Image size 1924x1556, UWF retinal mosaic.
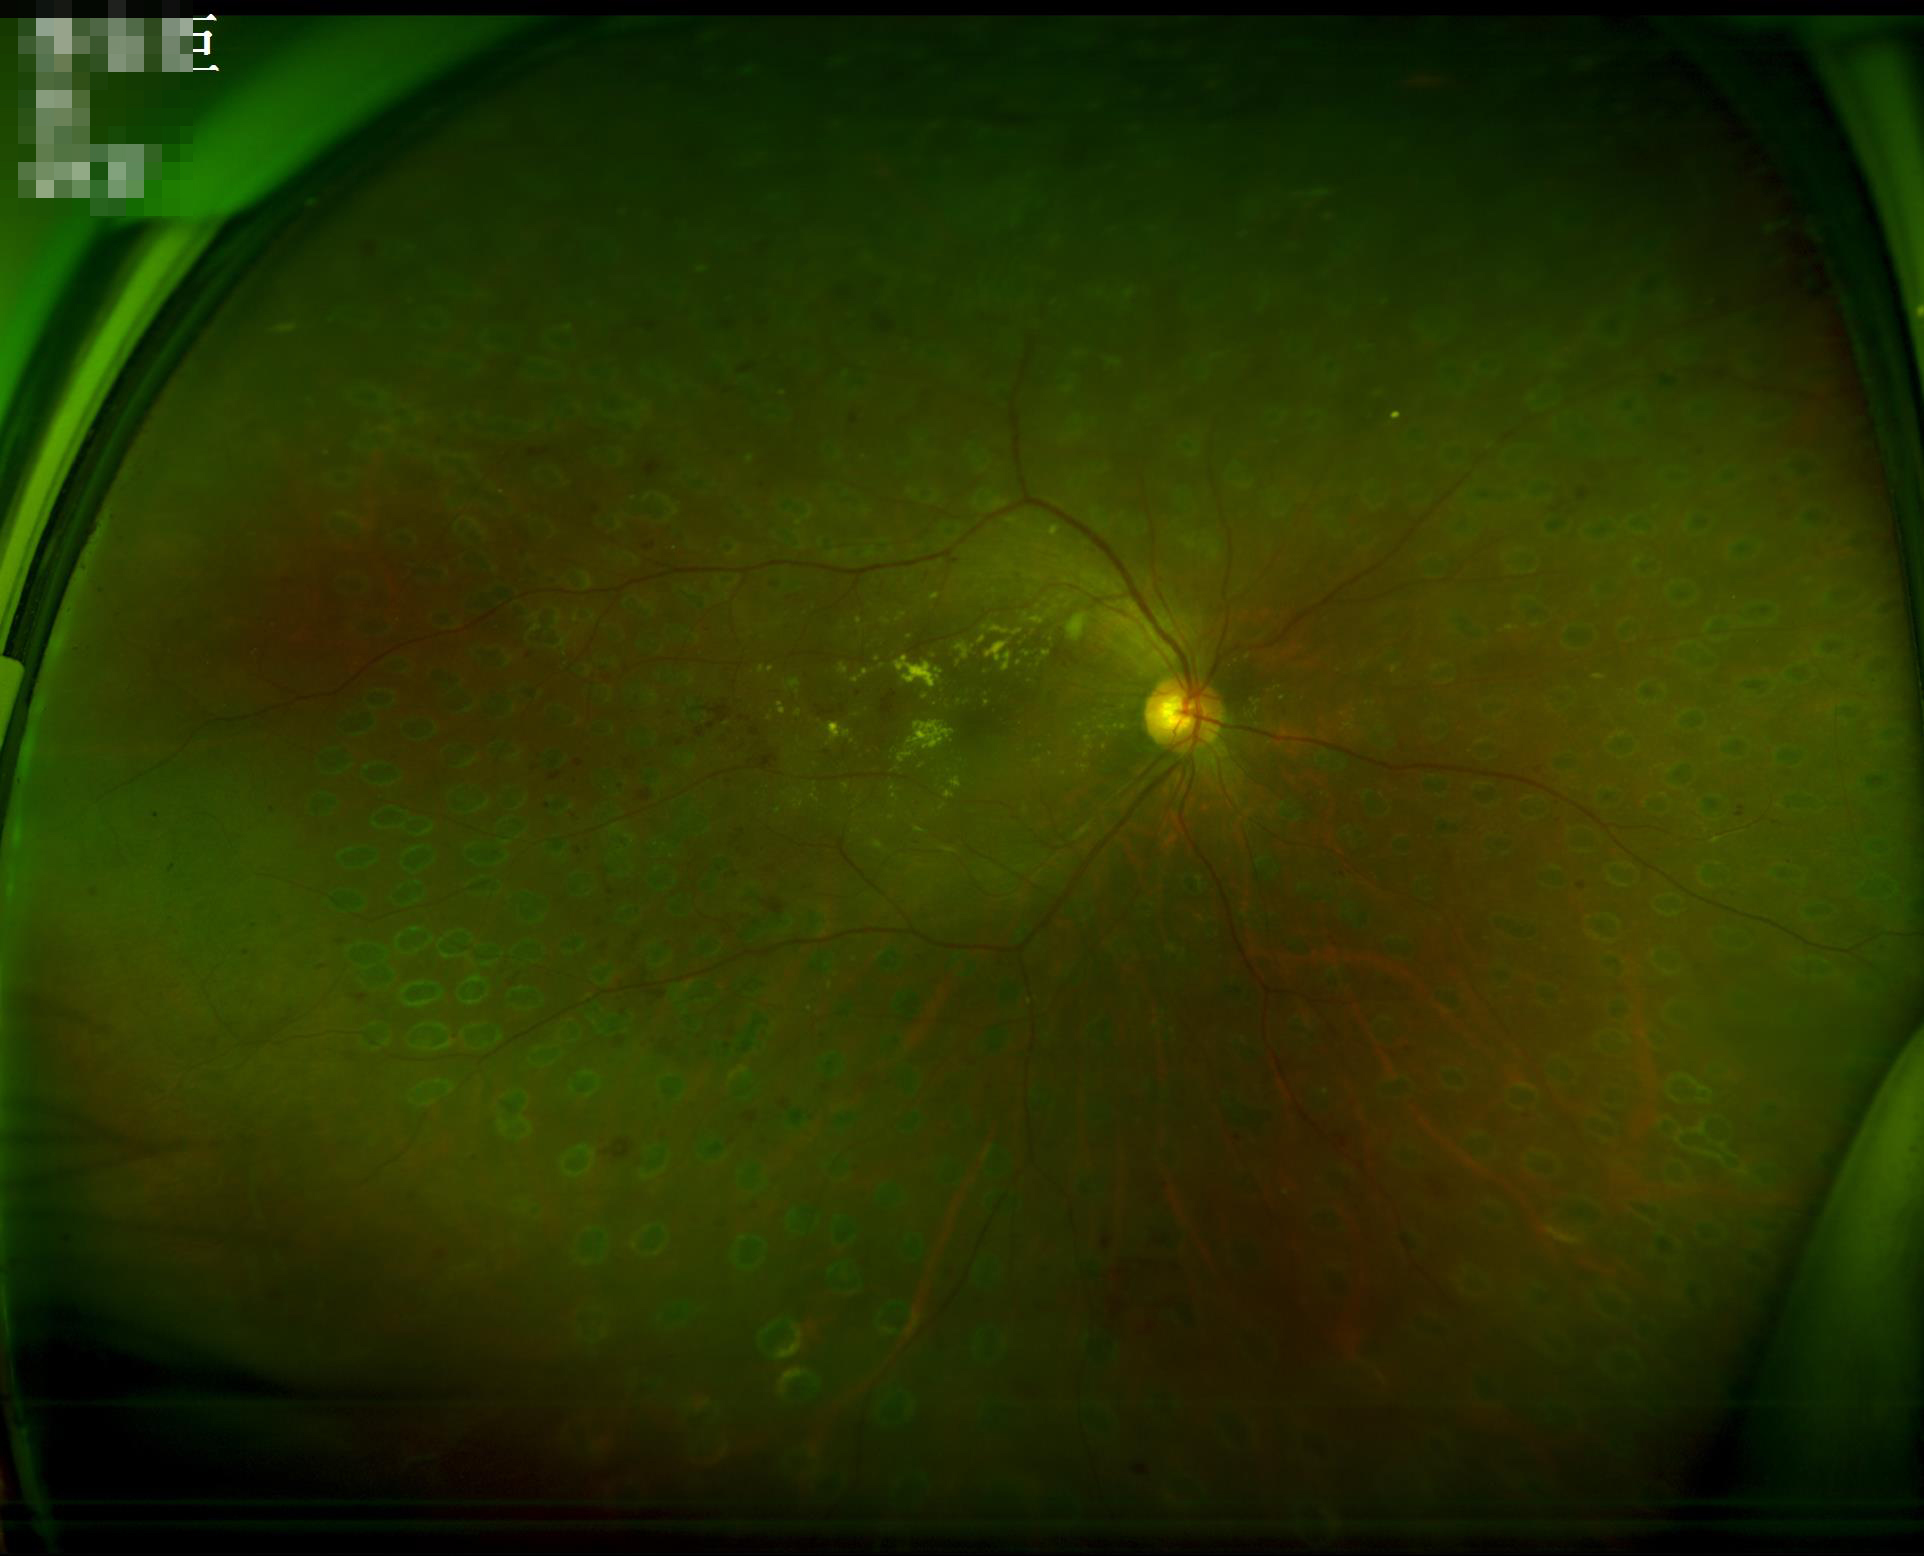

Image is sharp throughout the field.
Contrast is low.